Fundus photo:
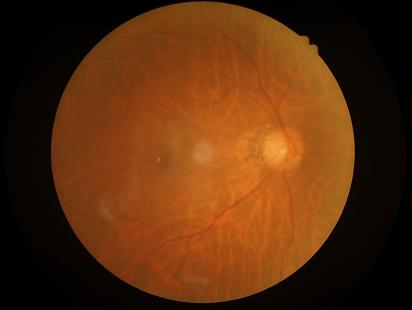

Illumination and color balance are good.
Overall quality is good and the image is gradable.
Good dynamic range.
Noticeable blur in the optic disc, vessels, or background.